Color fundus image · Topcon TRC-50DX · captured after pupil dilation · image size 2228x1652 · 50° FOV · central posterior field:
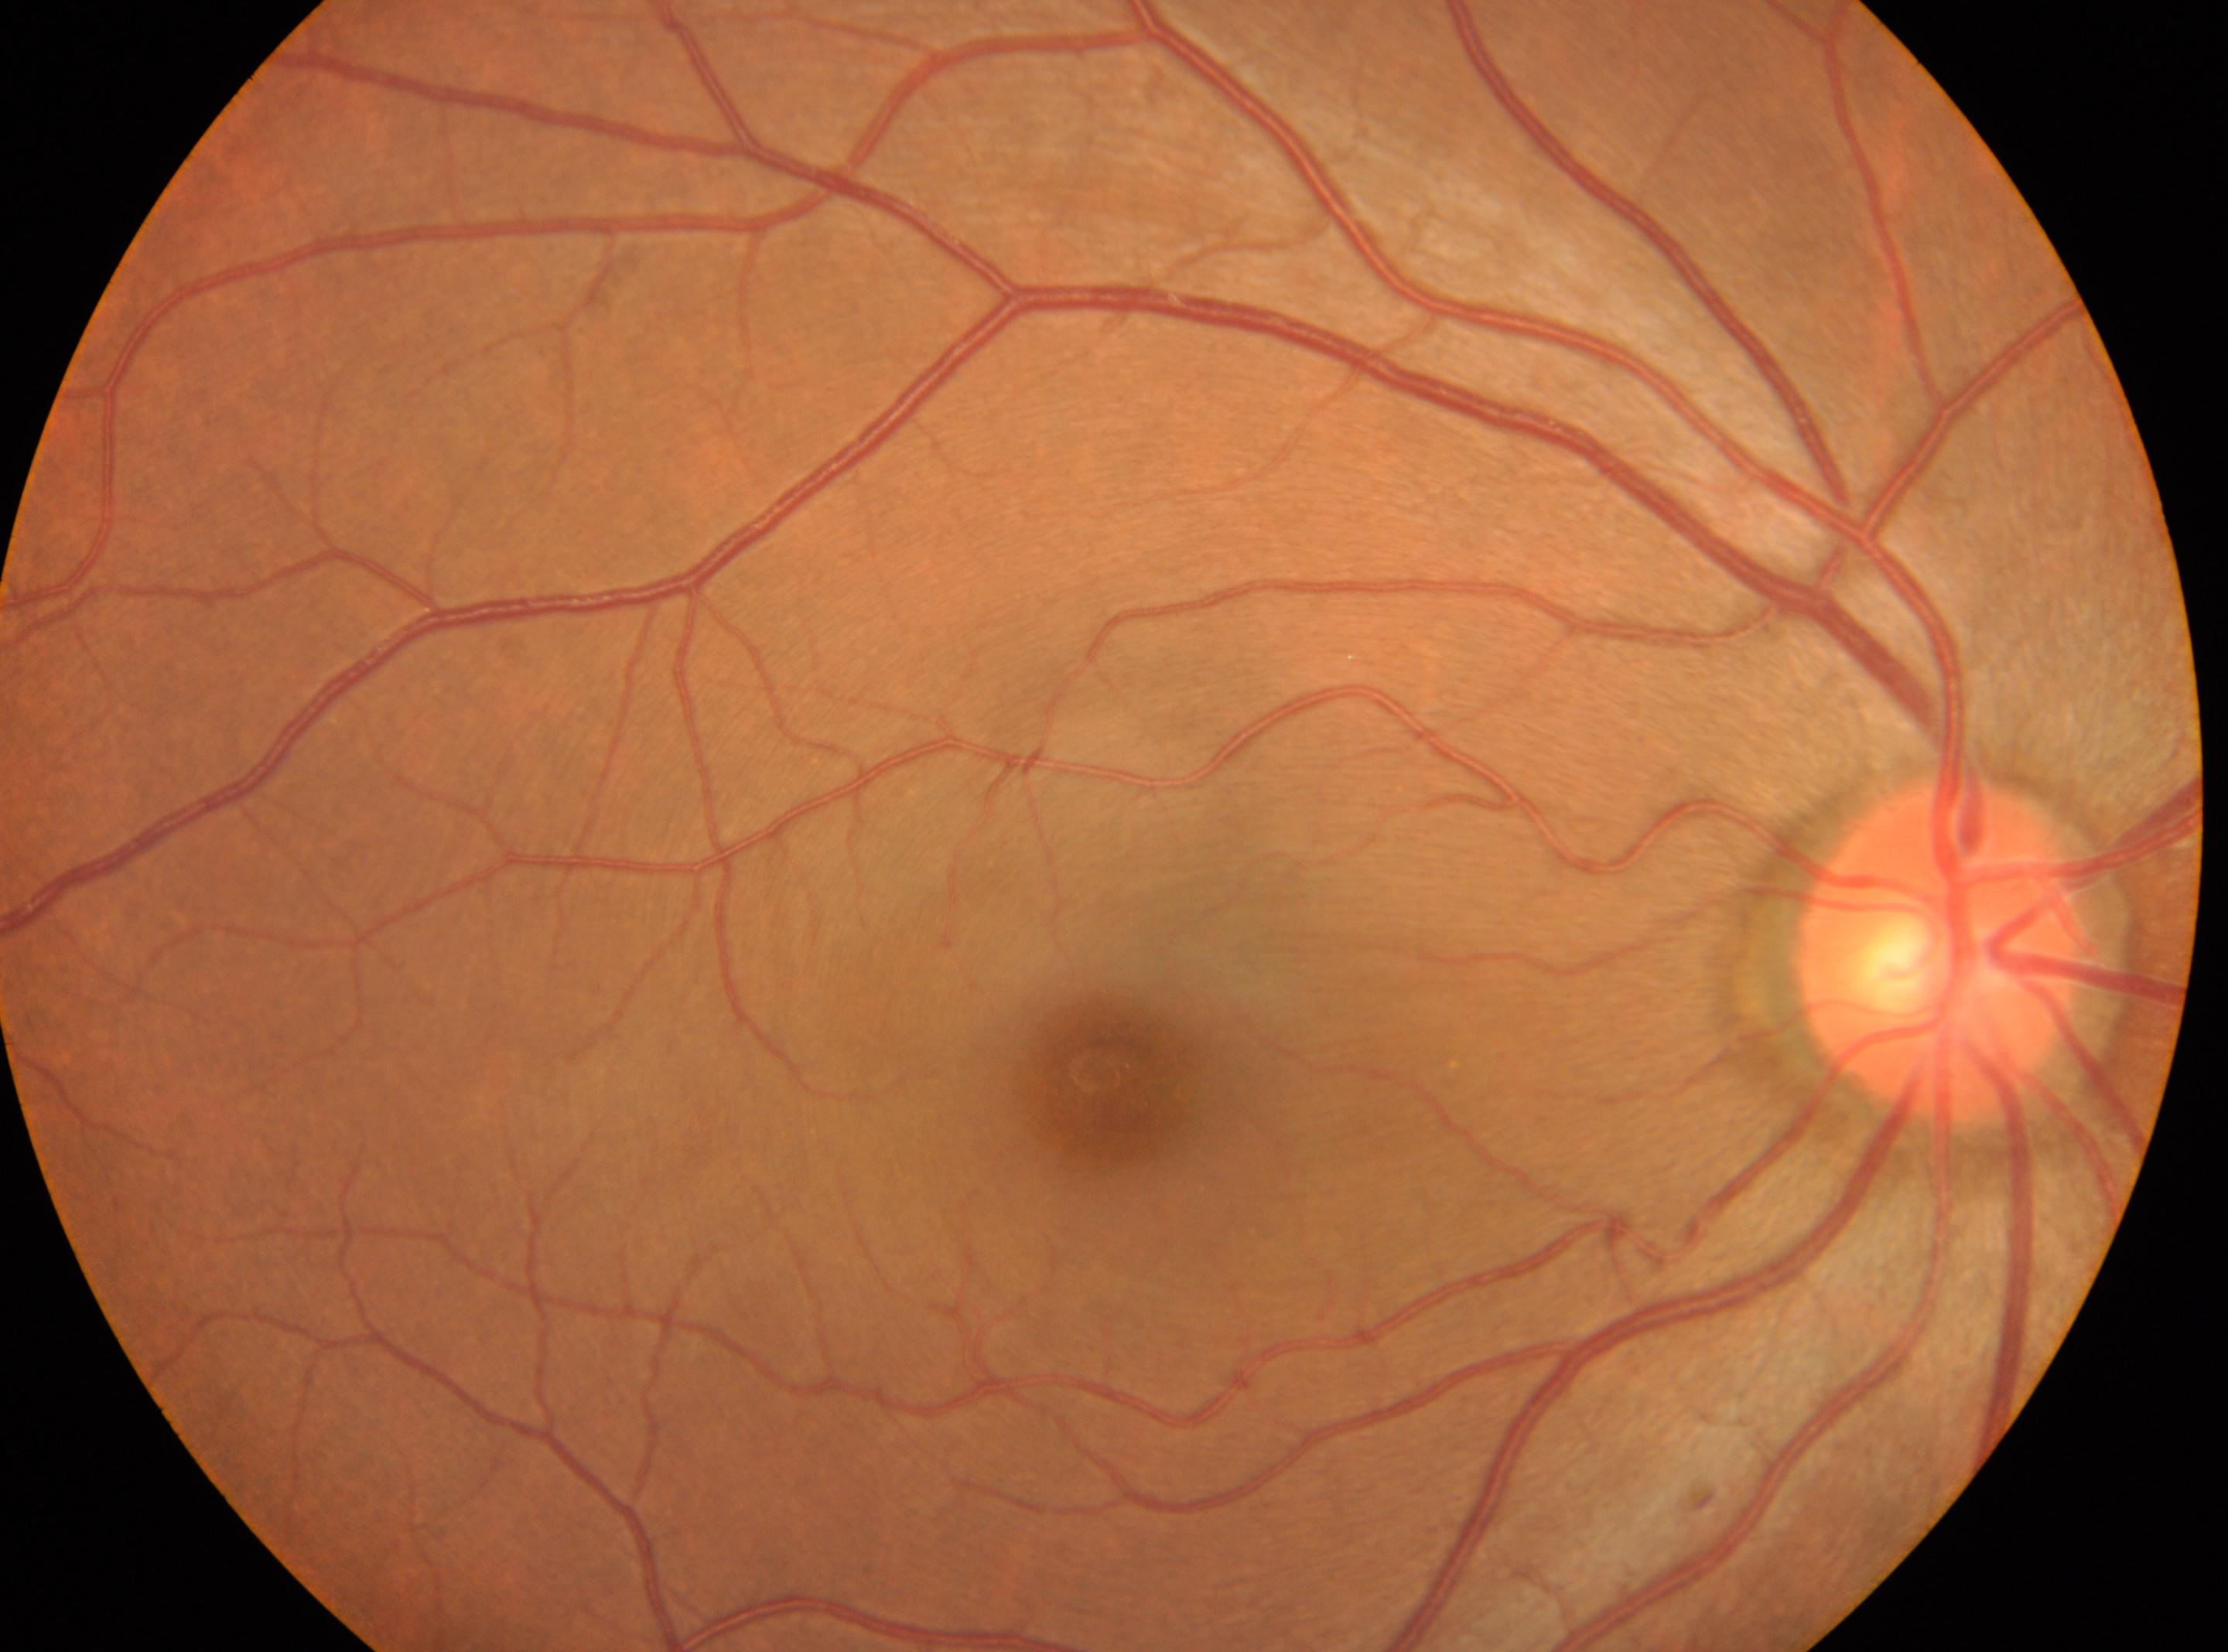
ONH located at [1939, 951]. The foveal center is at [1100, 1072]. DR grade is 0 (no apparent retinopathy). No signs of diabetic retinopathy. The image shows the right eye.